CFP, 45-degree field of view — 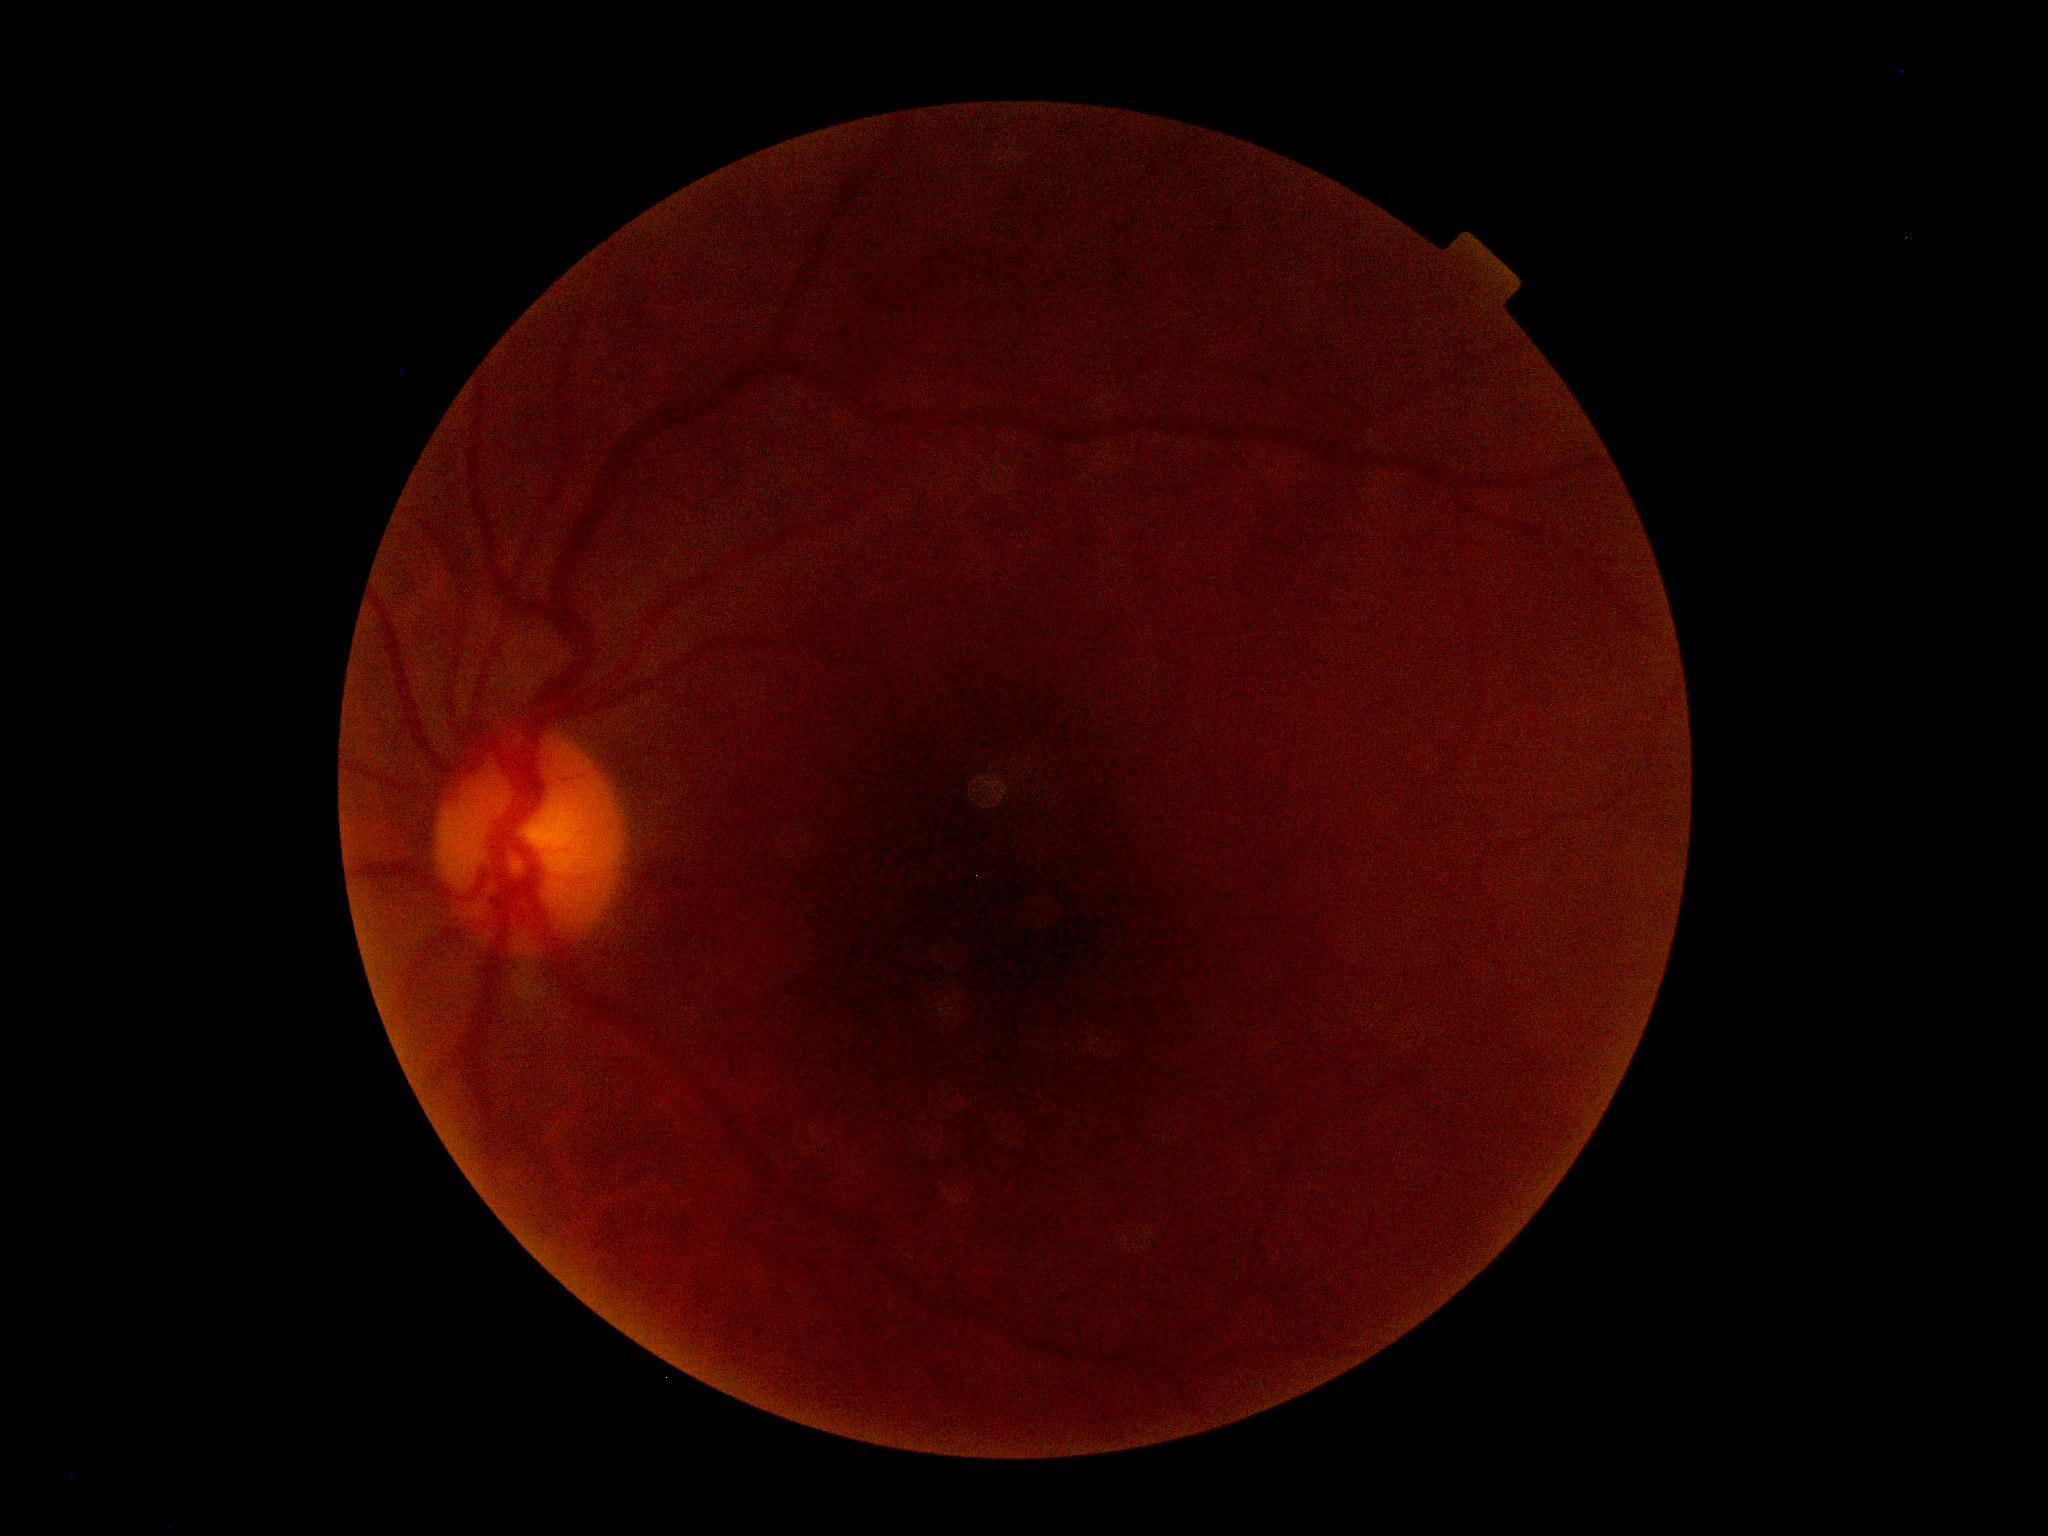
{
  "dr_grade": "ungradable",
  "quality": "insufficient"
}